848x848px, nonmydriatic fundus photograph.
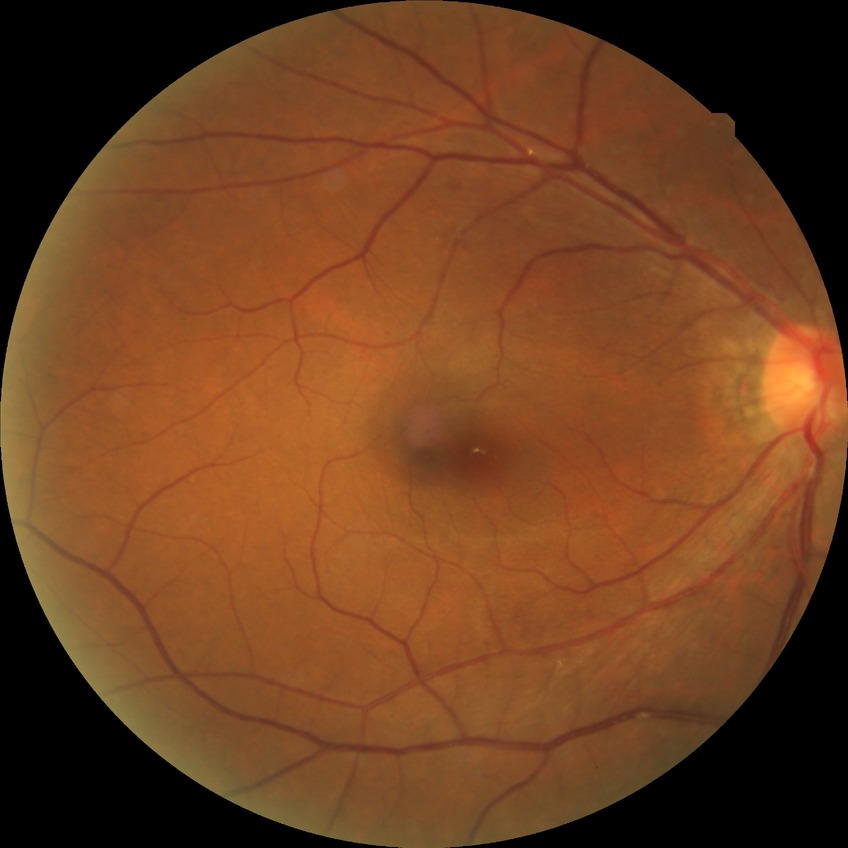 Diabetic retinopathy (DR) is simple diabetic retinopathy (SDR).